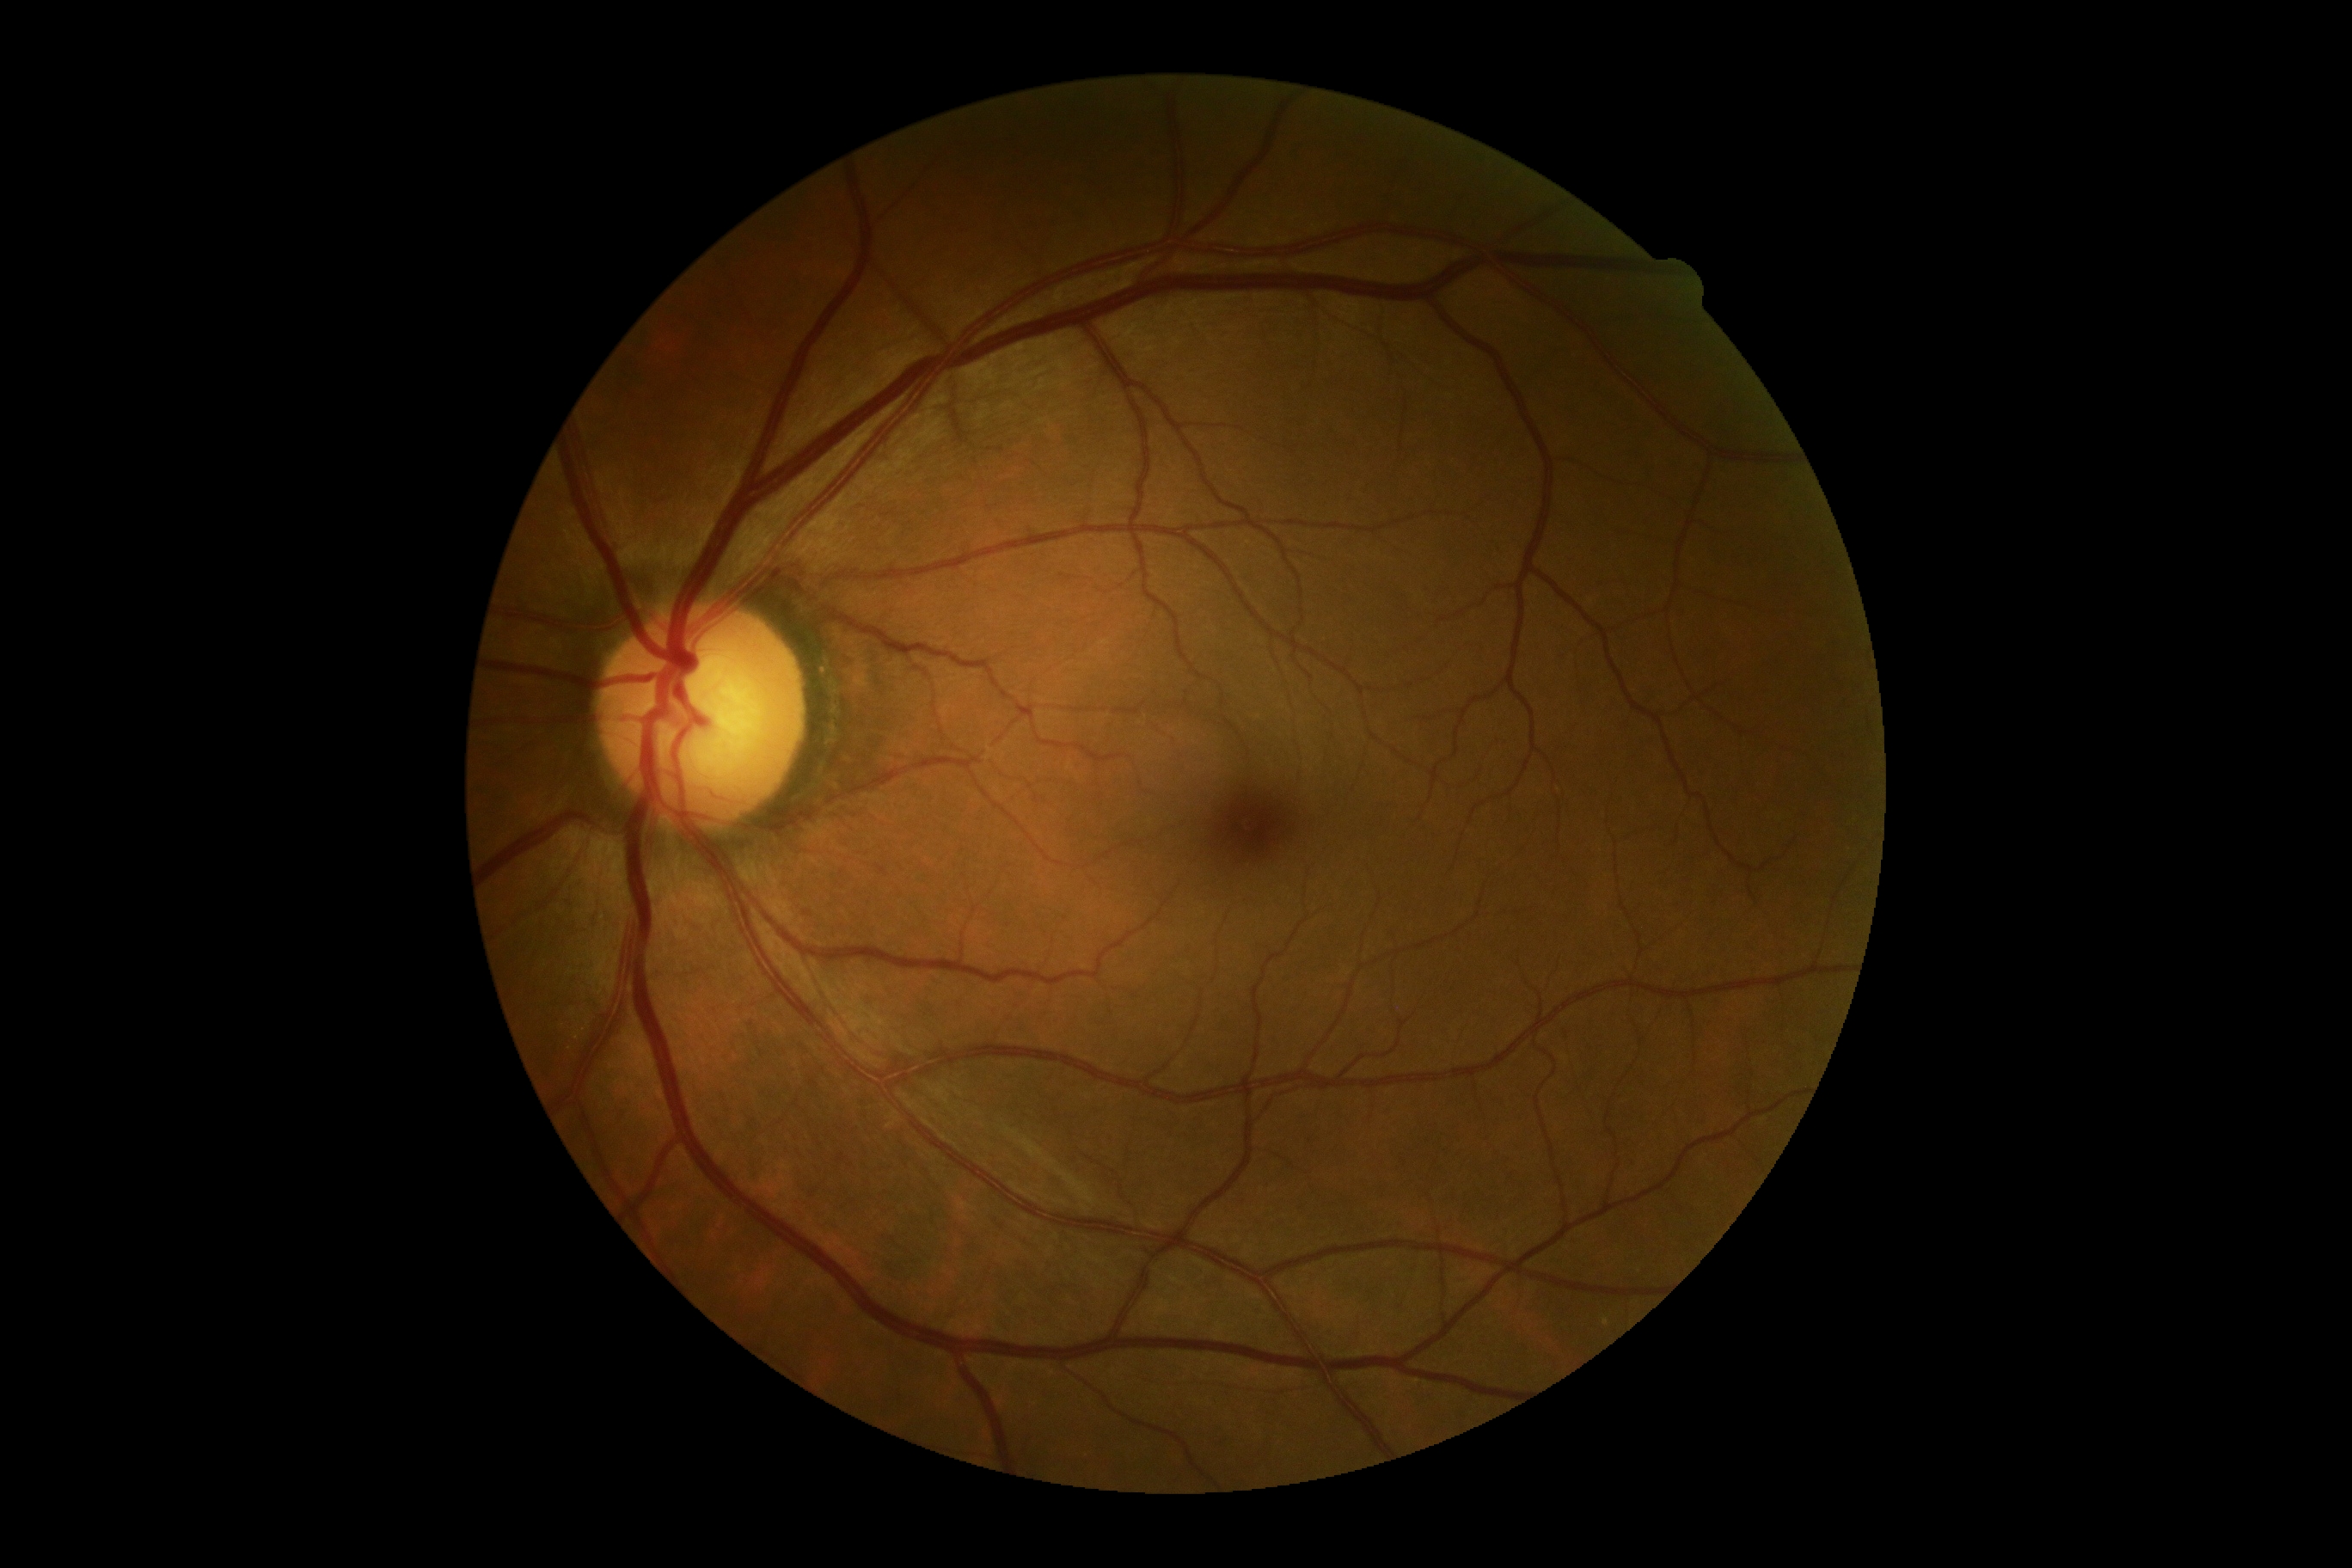

diabetic retinopathy severity=grade 0; DR impression=no signs of DR.